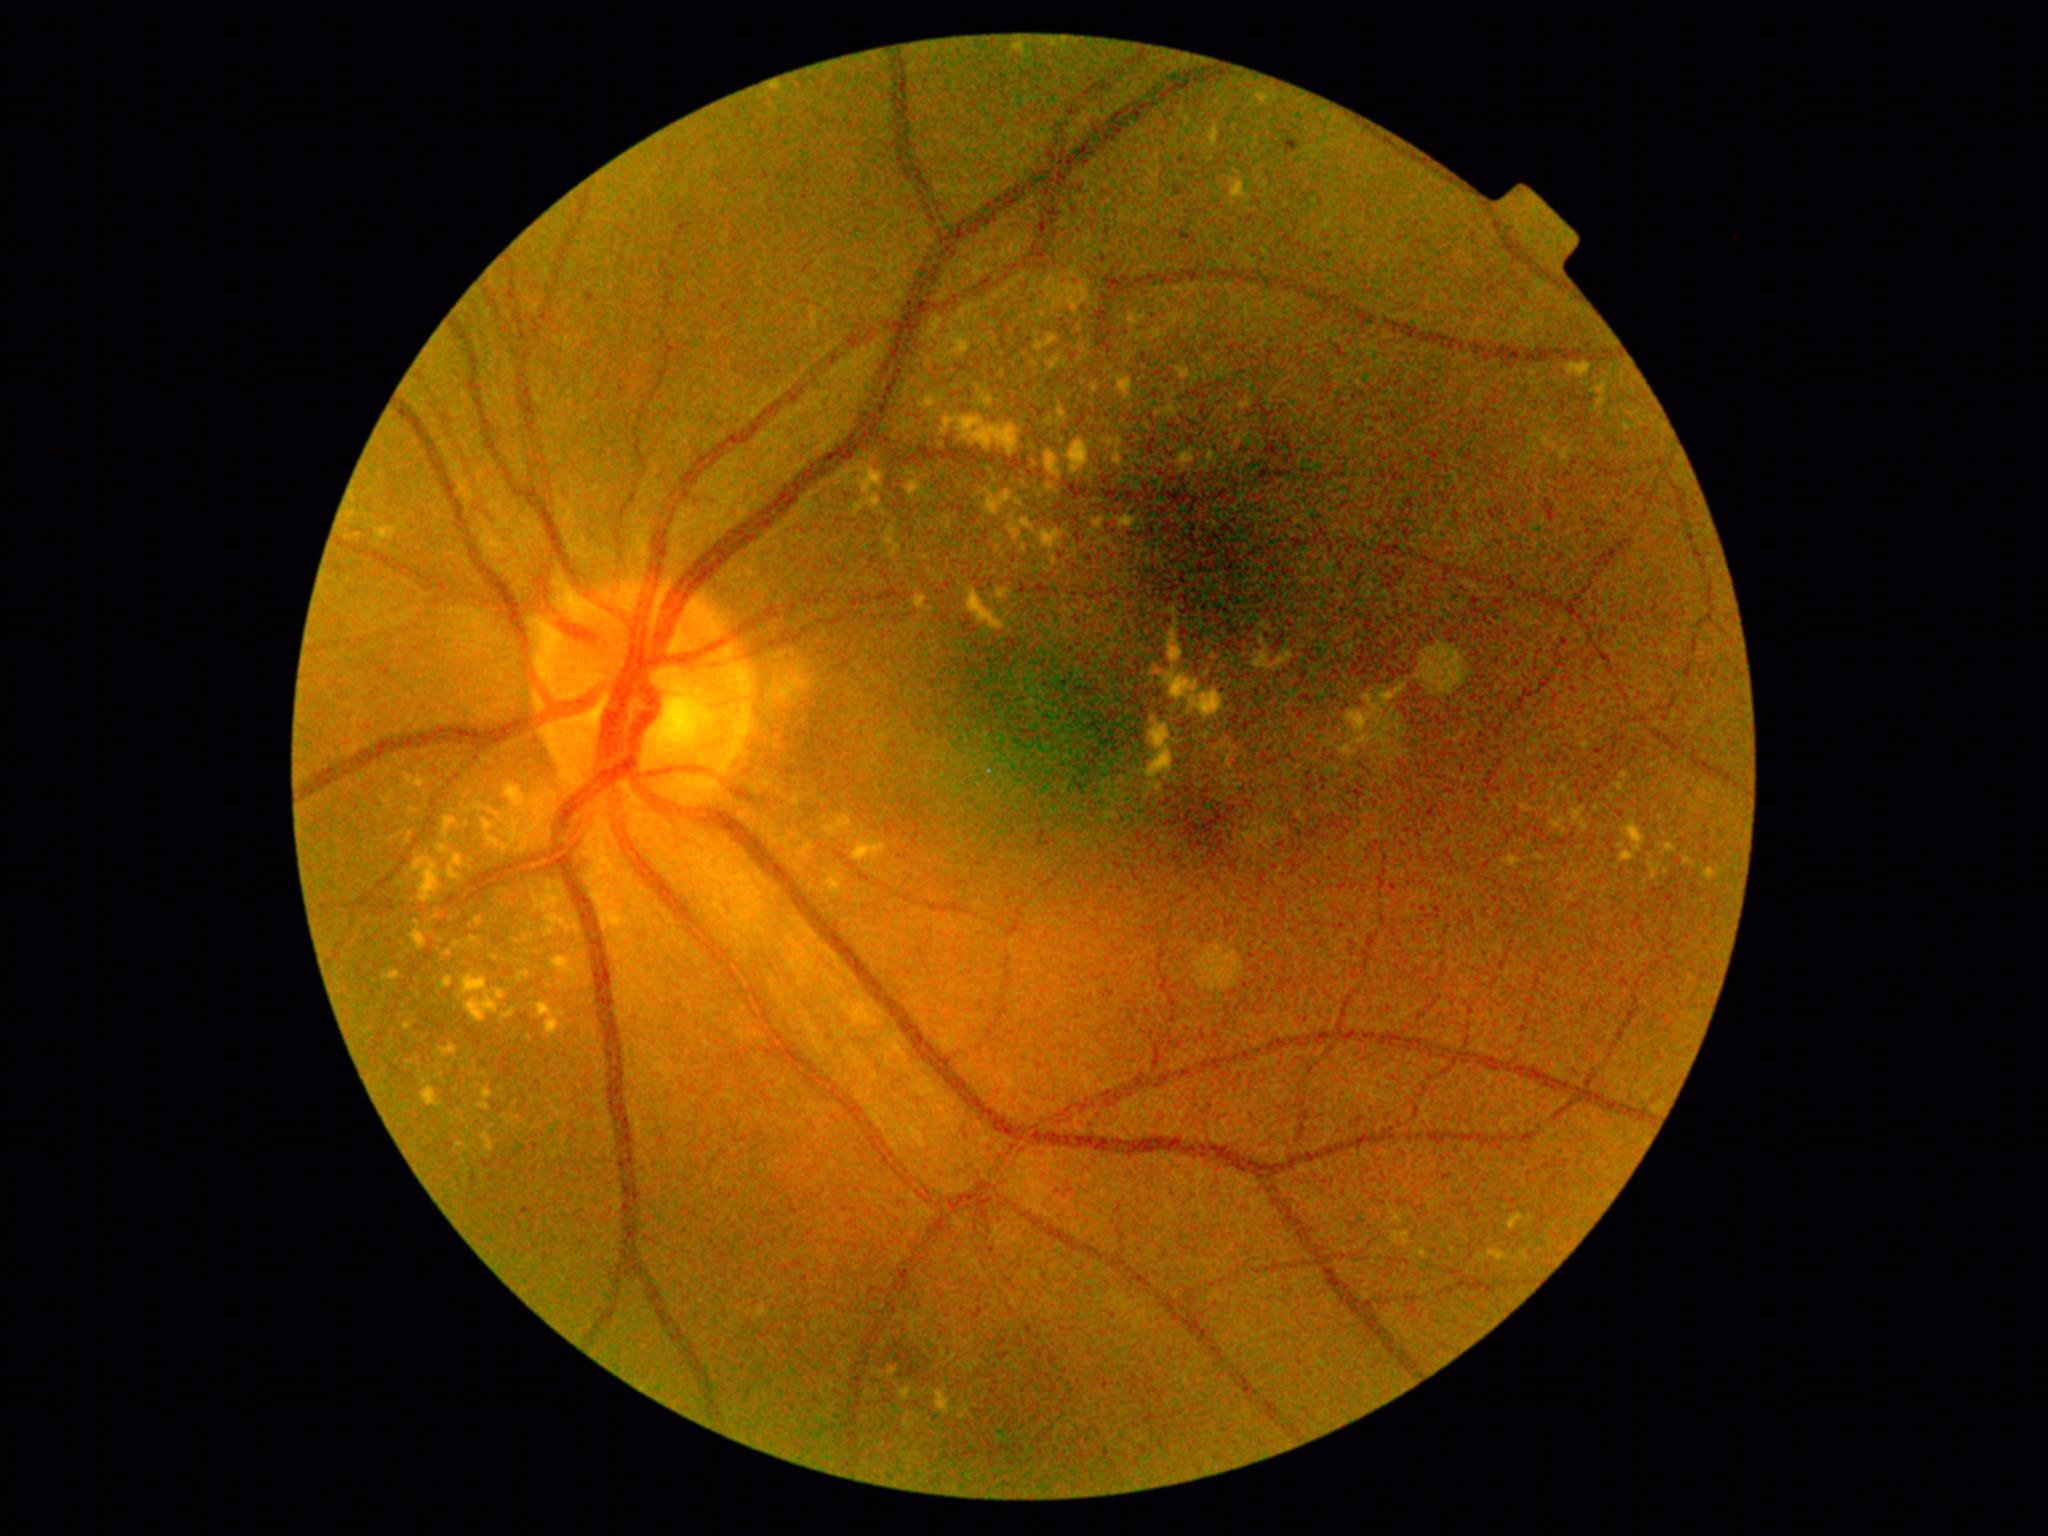
<lesions partial="true">
  <dr_grade>2</dr_grade>
  <ex partial="true">(1509,857,1520,867); (924,397,931,405); (908,487,918,494); (966,593,999,626); (901,1389,910,1398); (1380,688,1404,702); (1552,818,1563,829); (854,845,885,861); (482,1106,490,1110); (1232,182,1245,199); (512,829,519,842); (1182,453,1194,468)</ex>
  <ex_small>(414, 810); (551, 931); (407, 1027); (475, 940); (1033, 363)</ex_small>
</lesions>